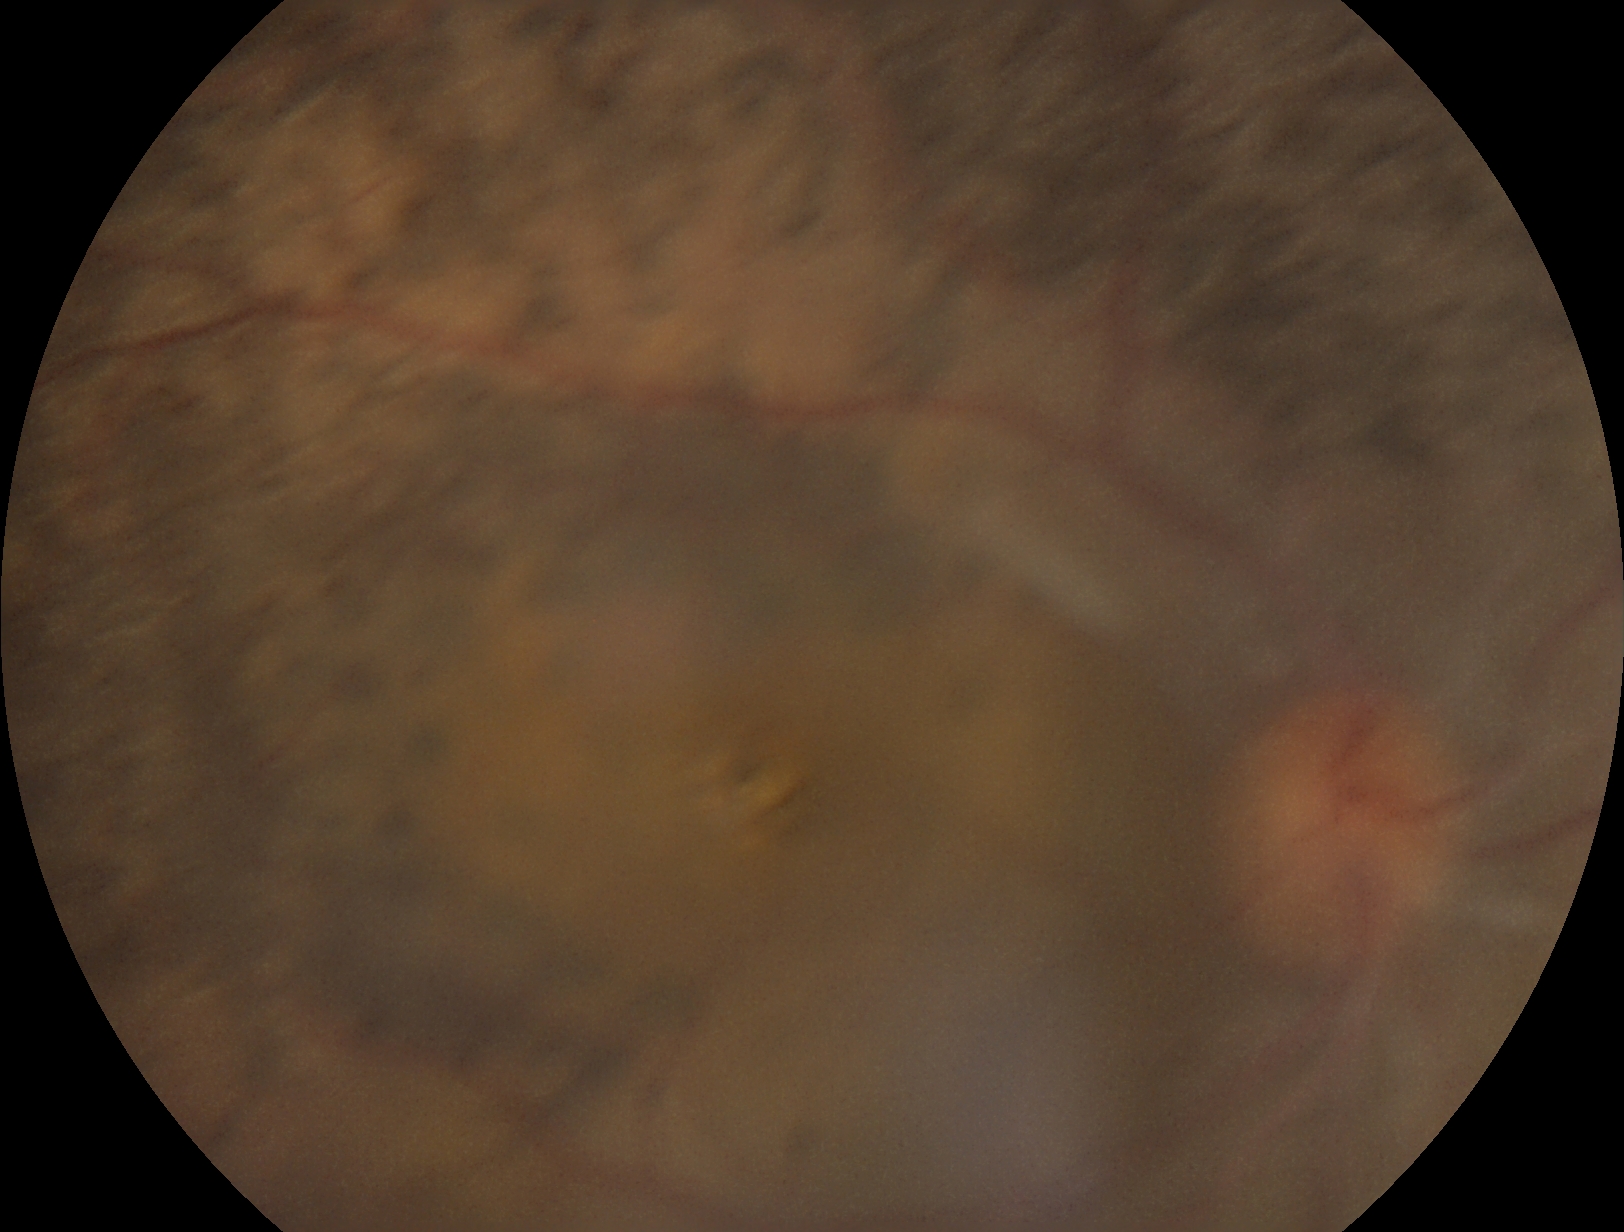

Retinopathy is ungradable due to poor image quality.